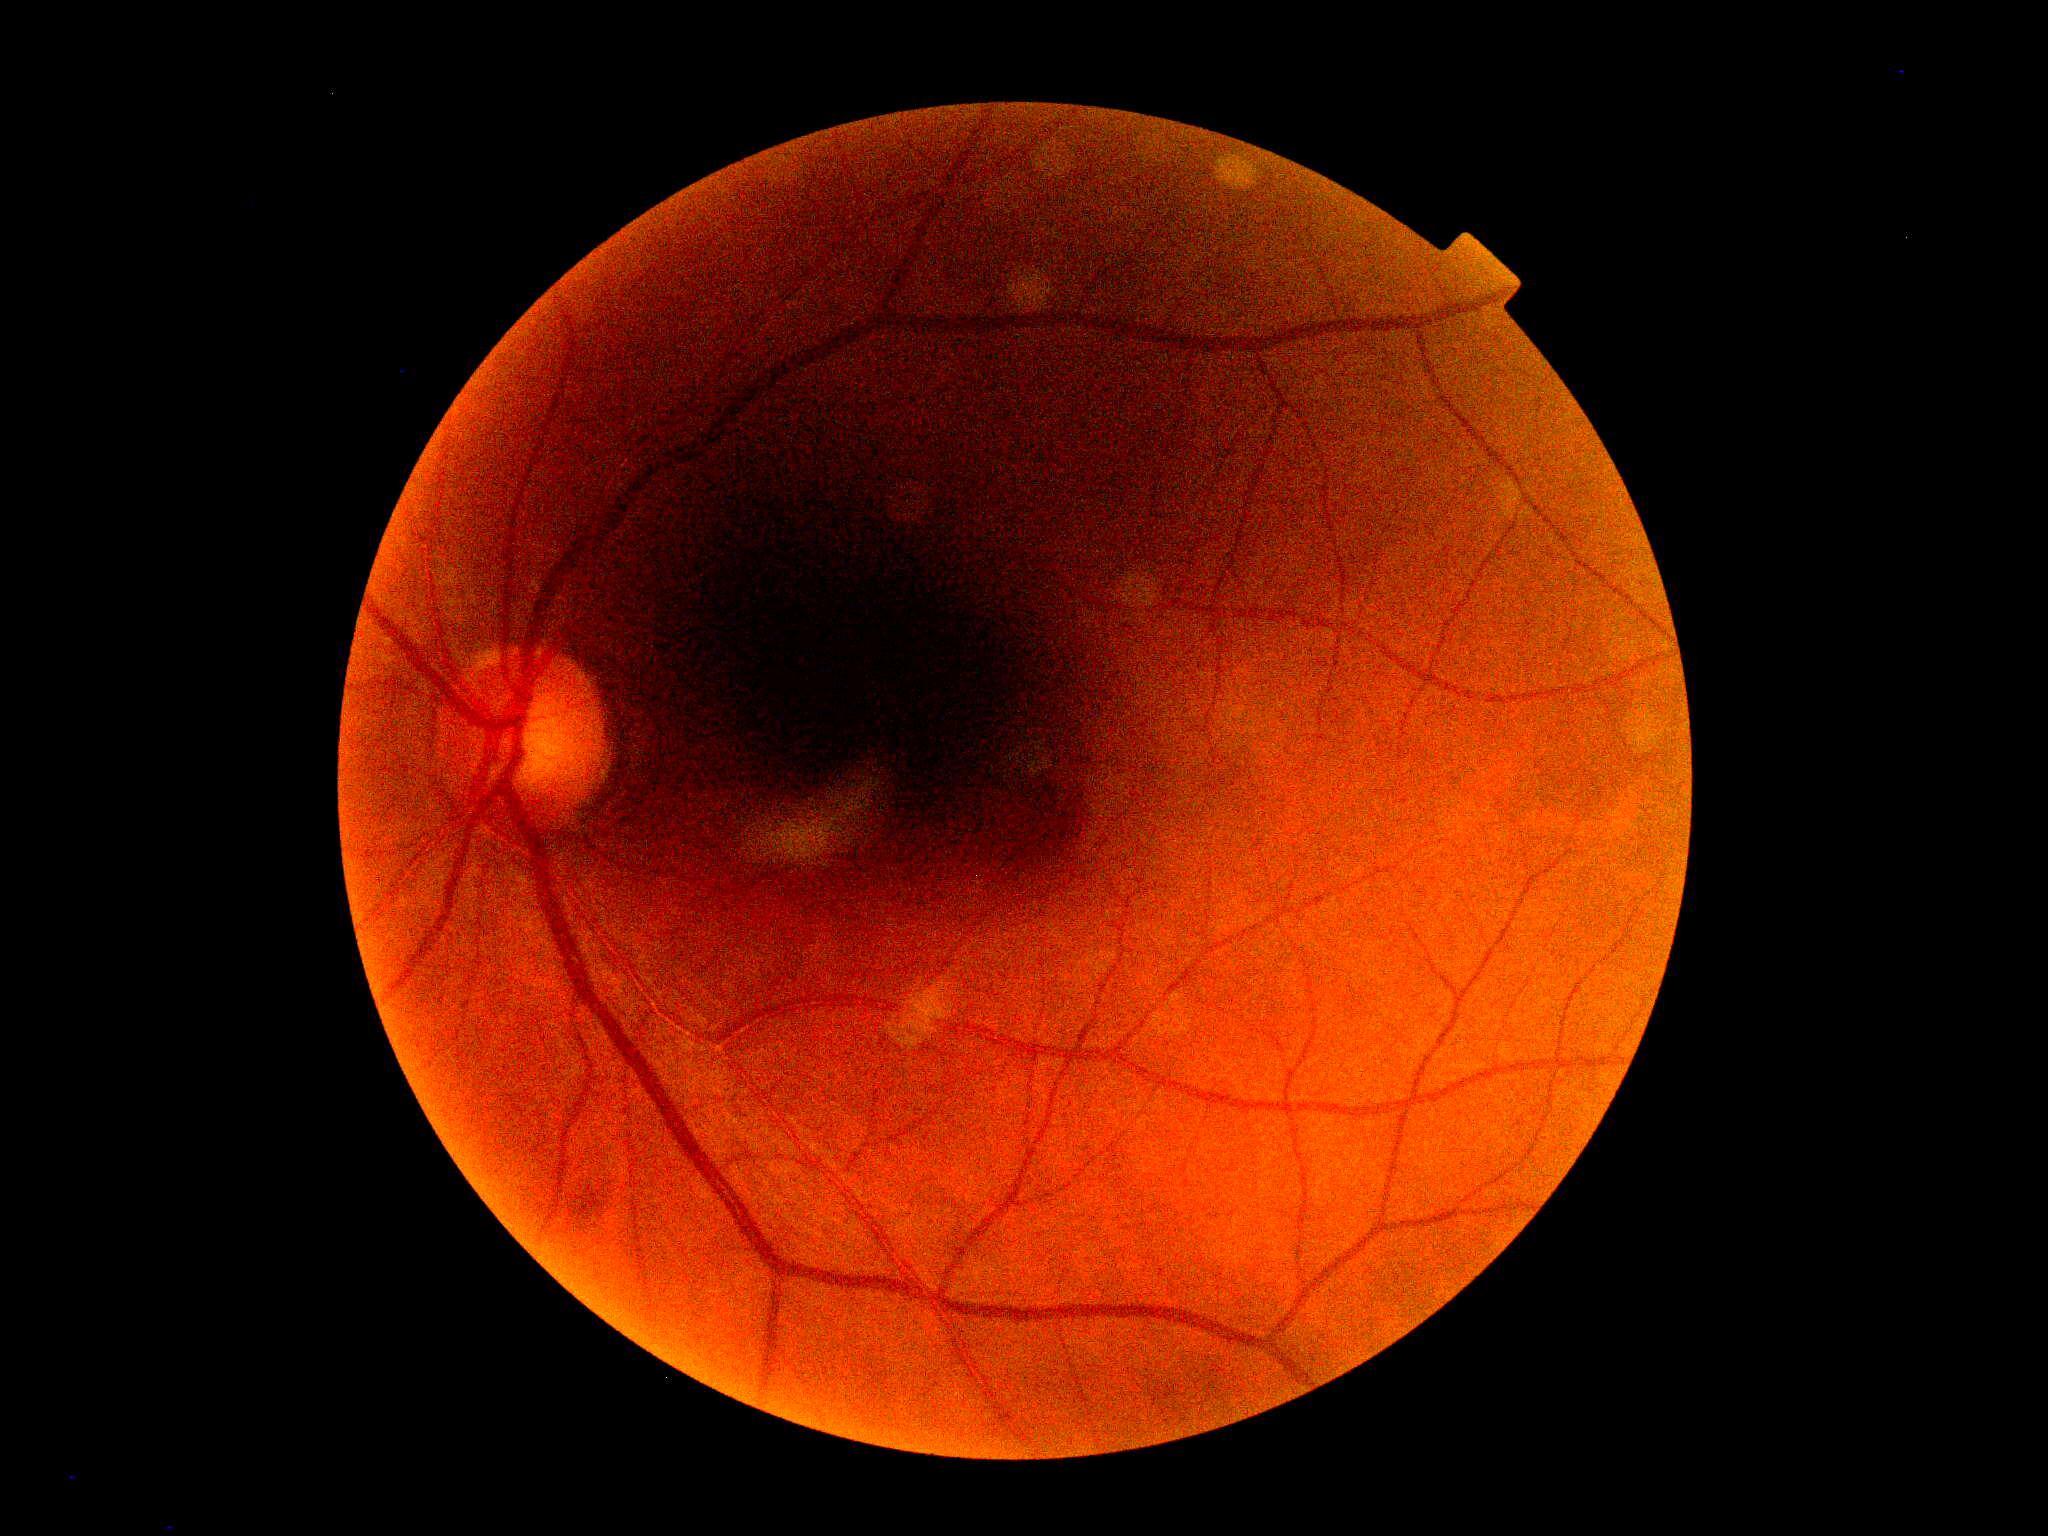
dr_grade: no apparent retinopathy (grade 0)